Color fundus photograph
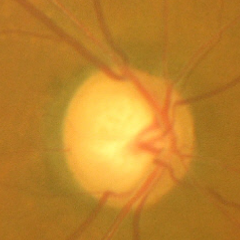

Advanced glaucoma.